848x848px: 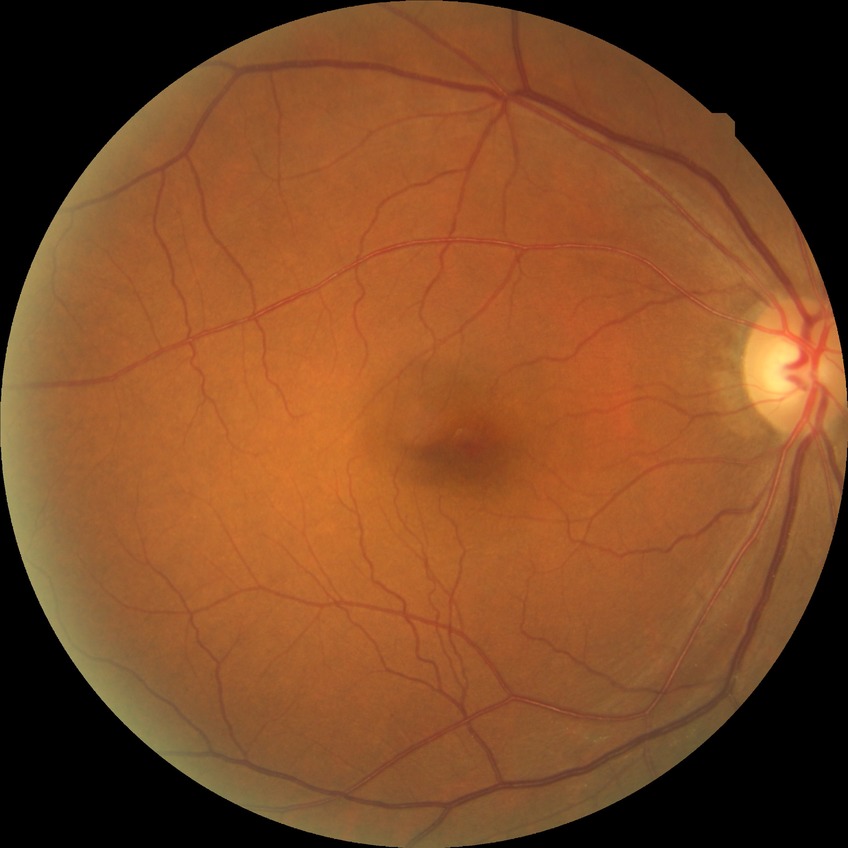

Diabetic retinopathy stage: no diabetic retinopathy.